NIDEK AFC-230 fundus camera · retinal fundus photograph — 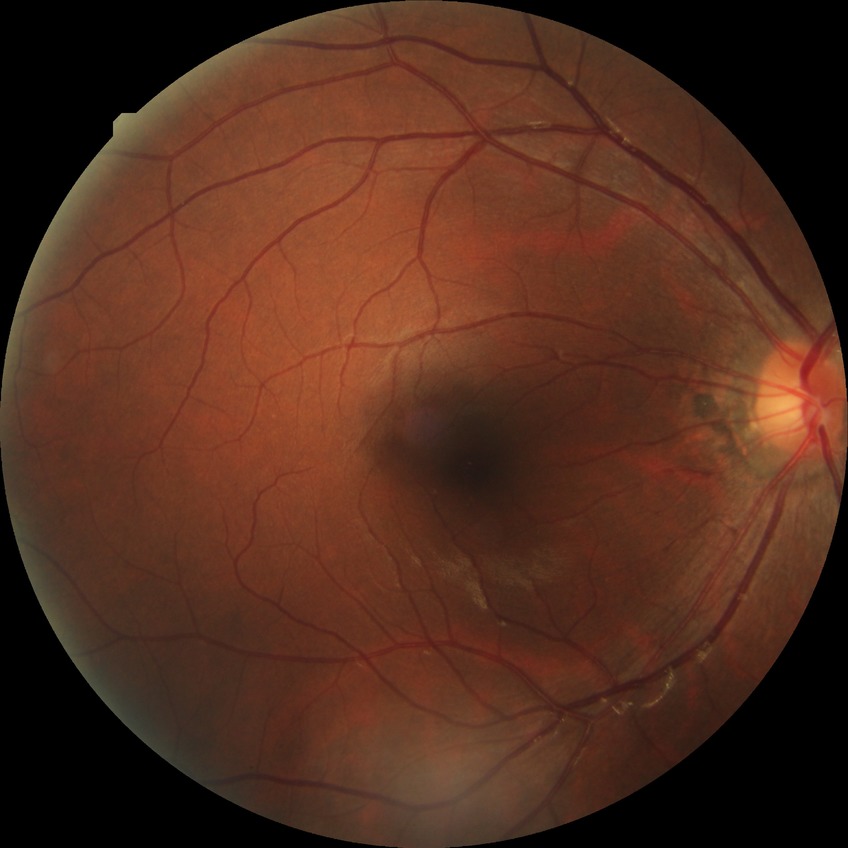
modified Davis grading: no diabetic retinopathy